Nonmydriatic fundus photograph:
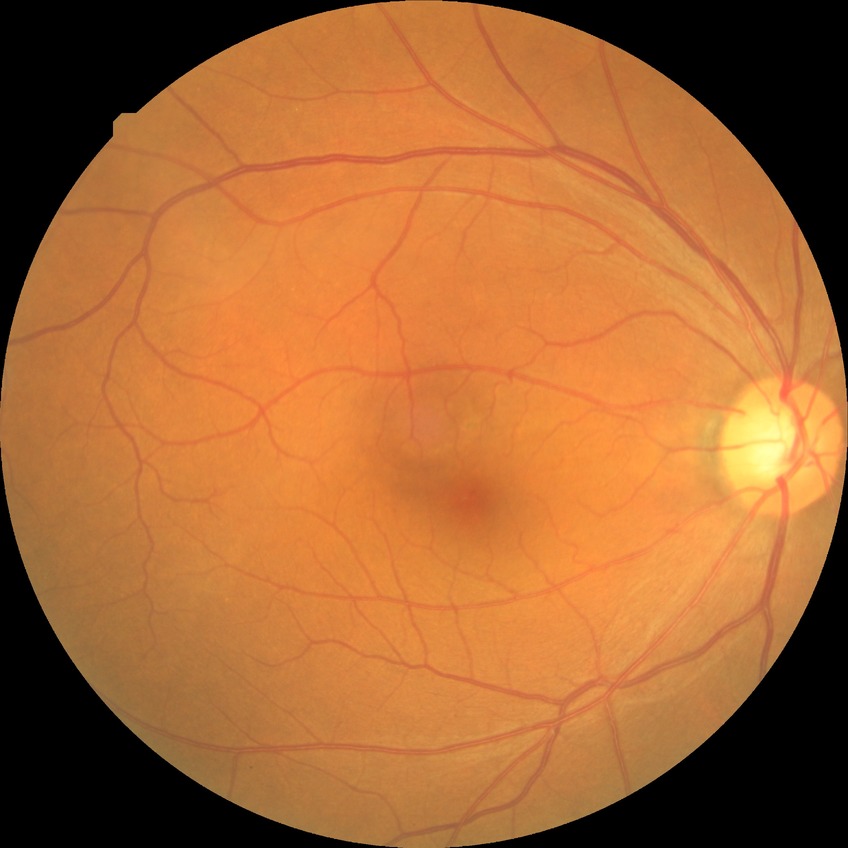
retinopathy grade: no diabetic retinopathy.